Captured on a Remidio Fundus on Phone · CFP: 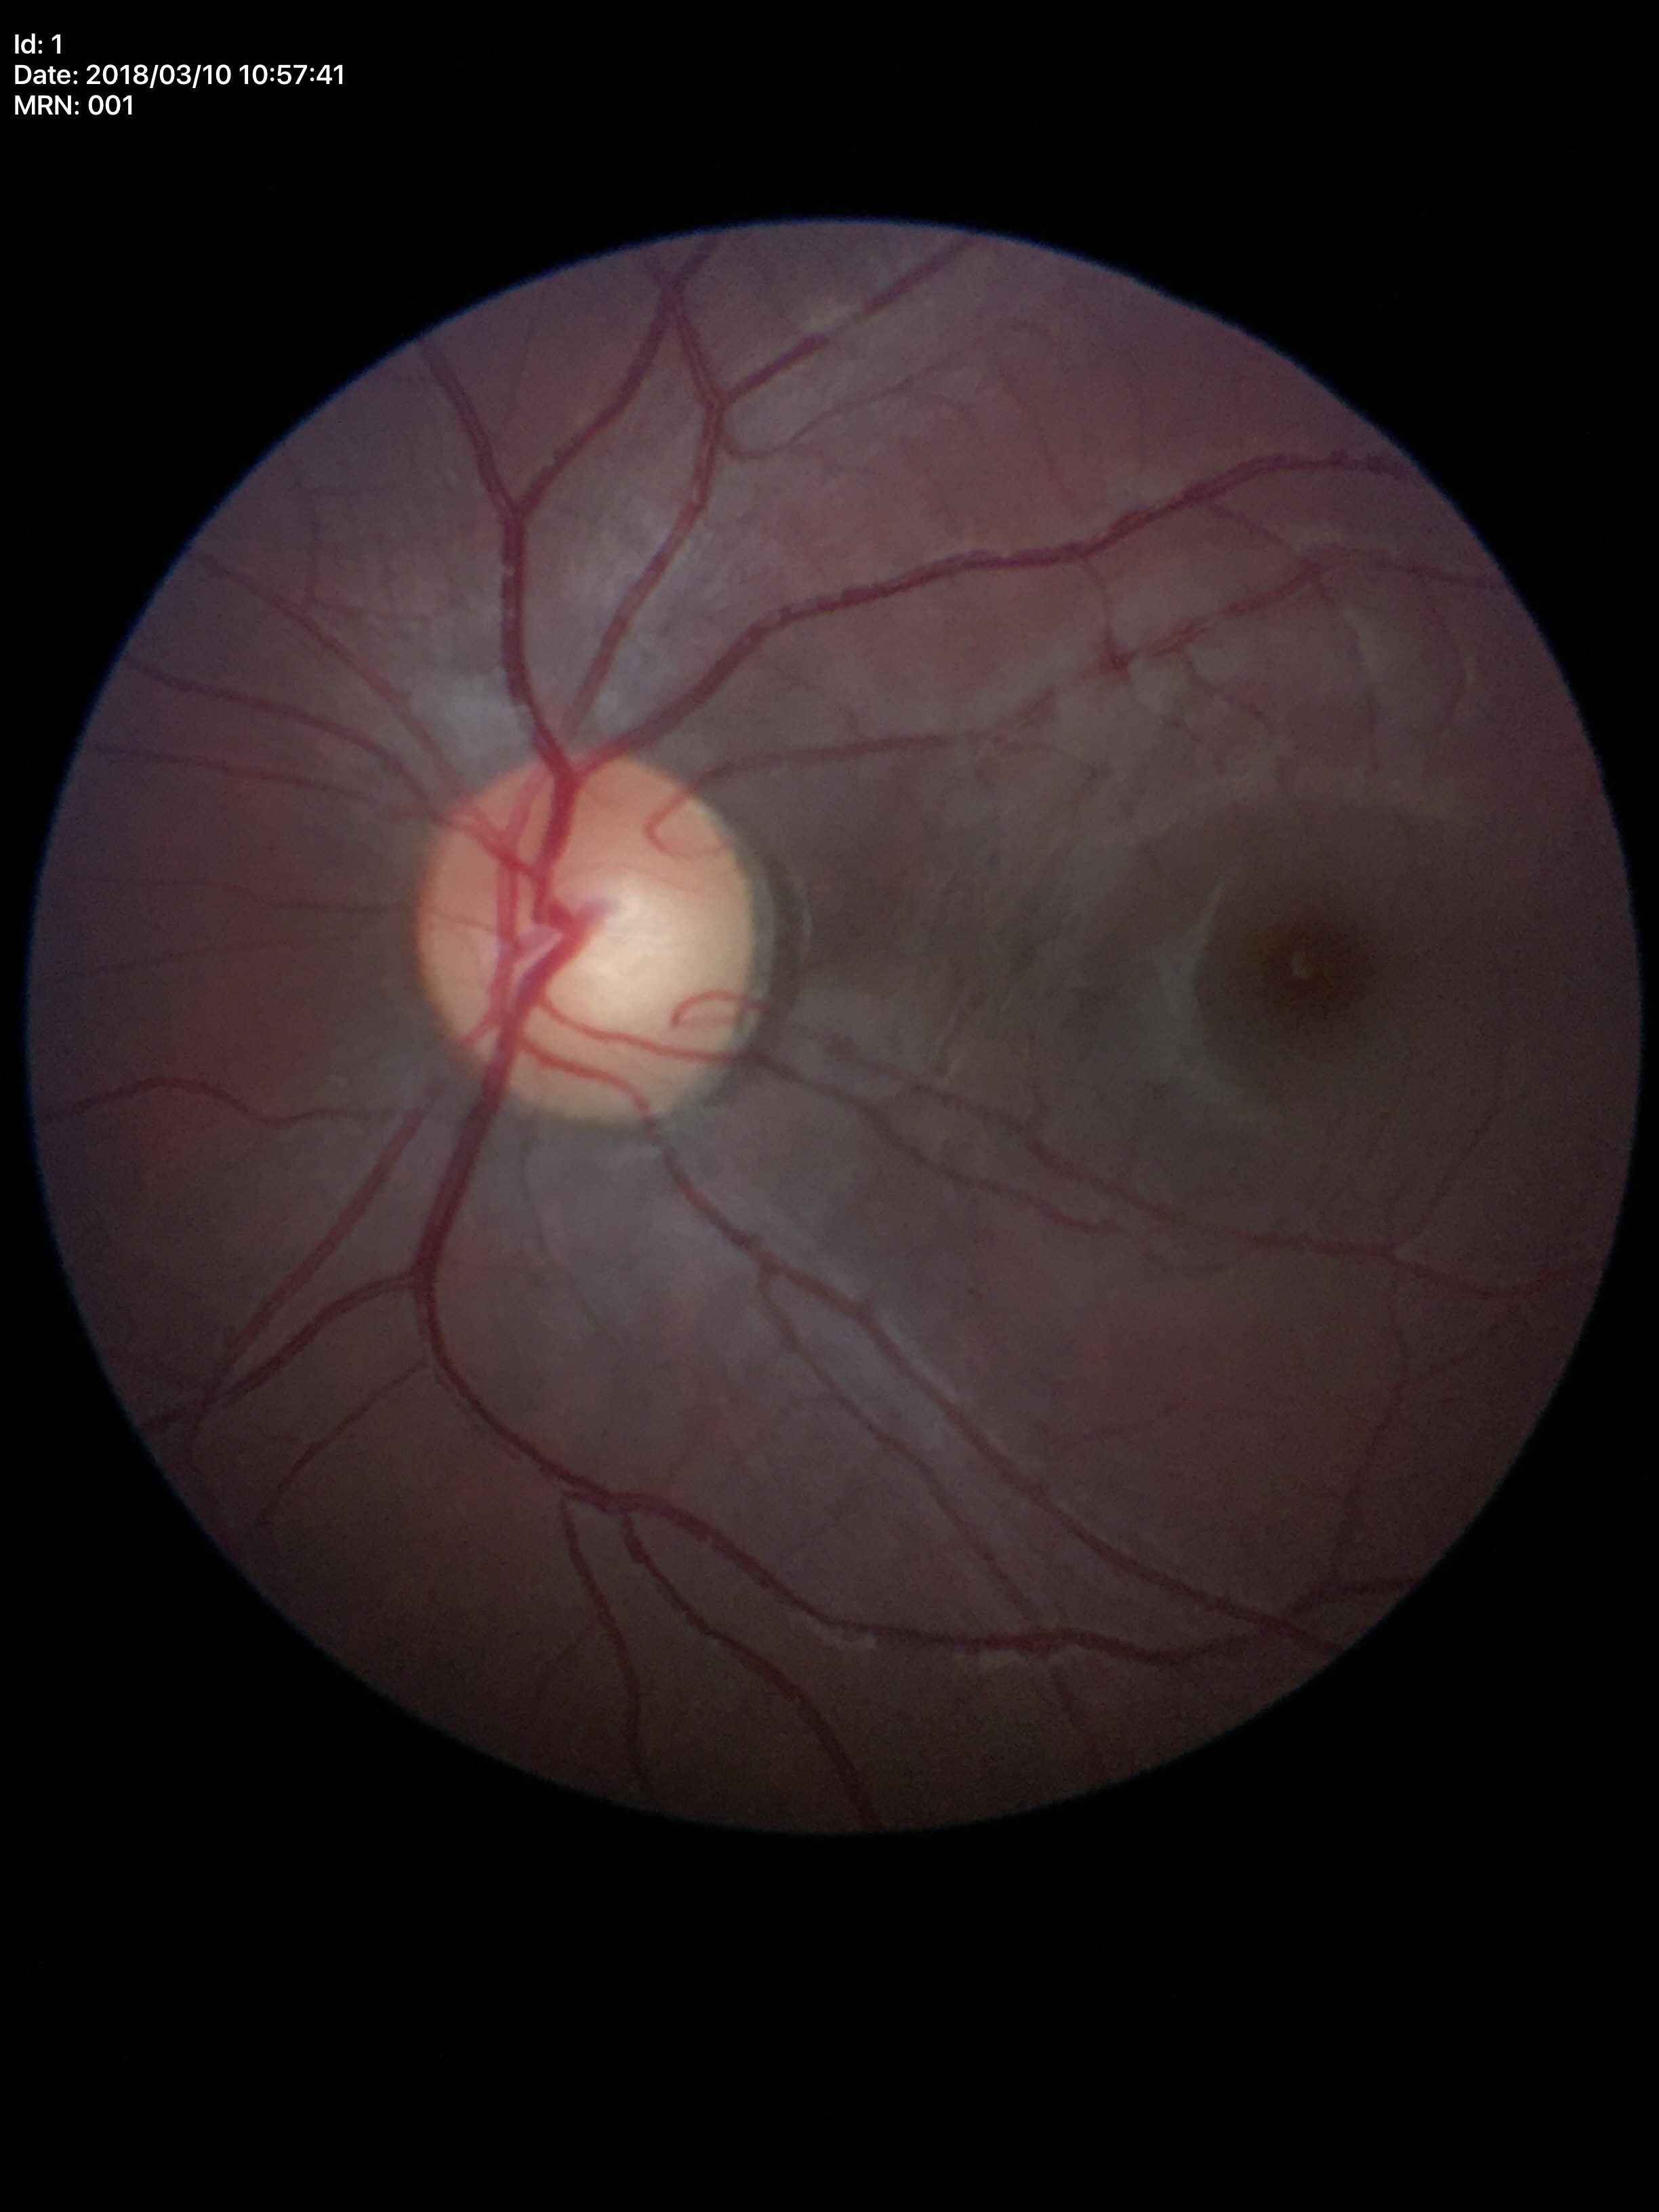
Q: What is the glaucoma assessment?
A: not suspect (unanimous normal call)
Q: What is the VCDR?
A: 0.49
Q: Horizontal CDR?
A: 0.55